Patient age: 39 years · axial length (AL) 23.5 mm · refractive error: +0.75 -0.25 × 175° — 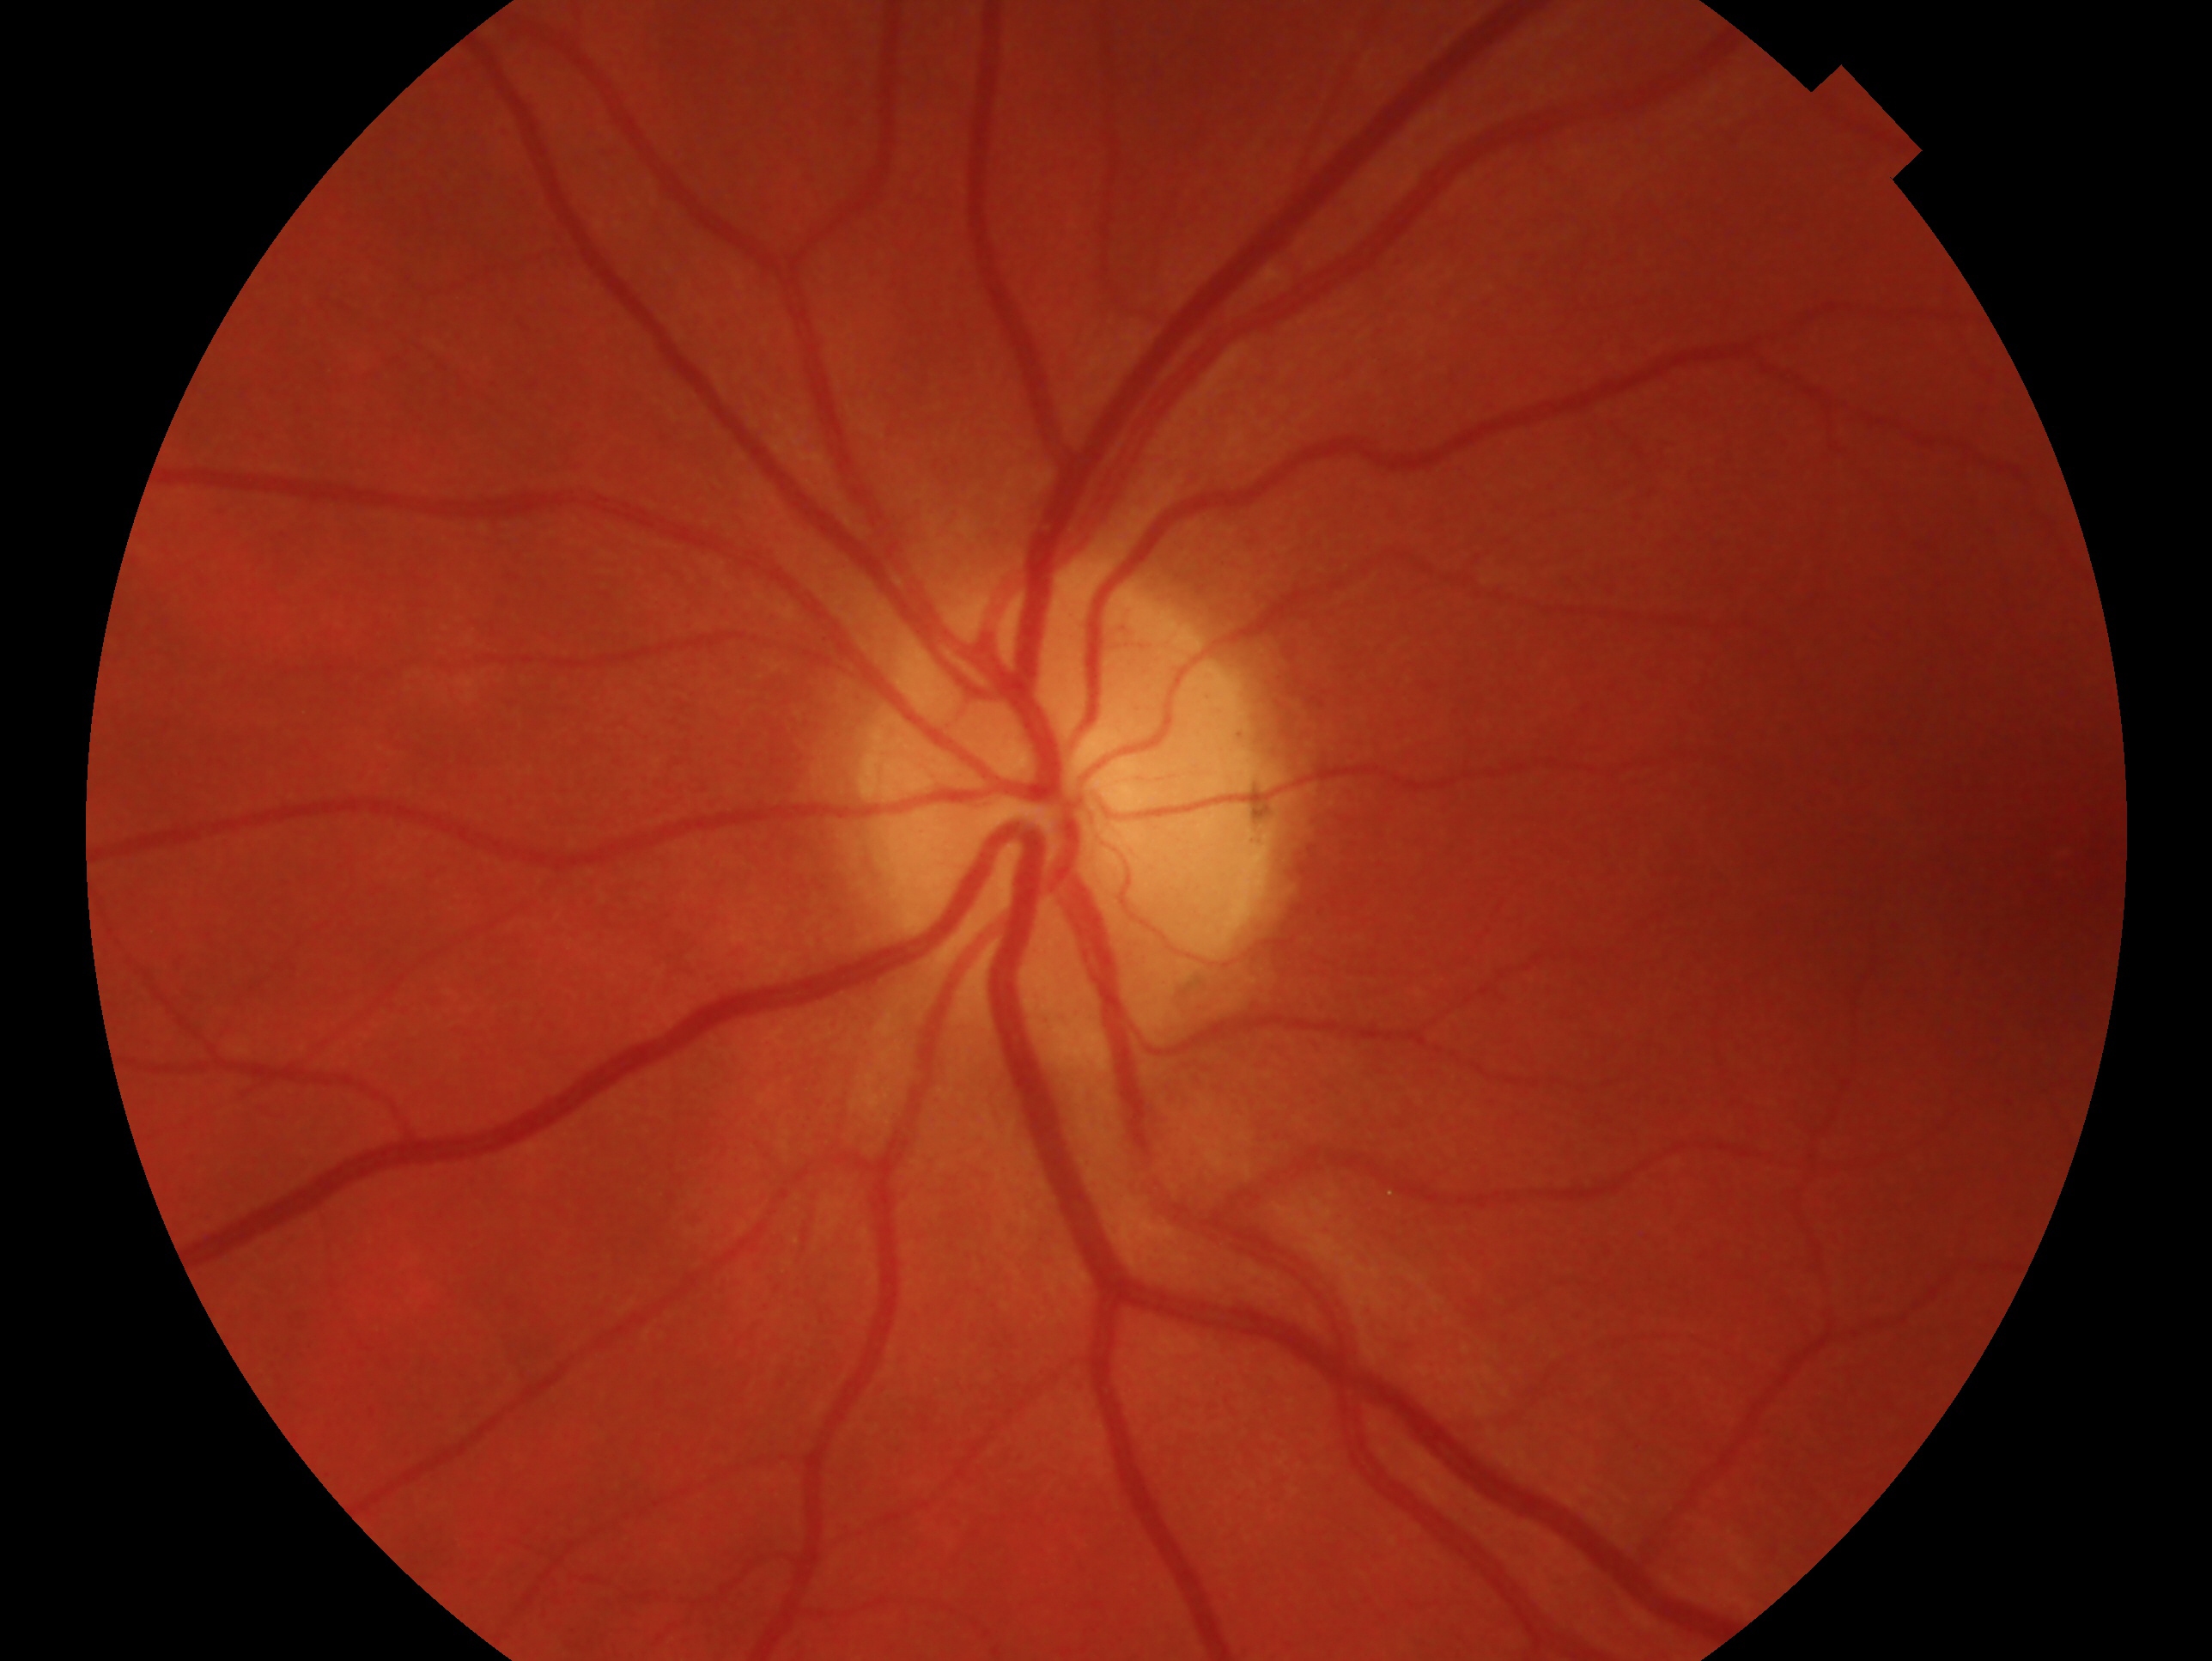

Eye: OS.
Clinical classification: no signs of glaucoma.